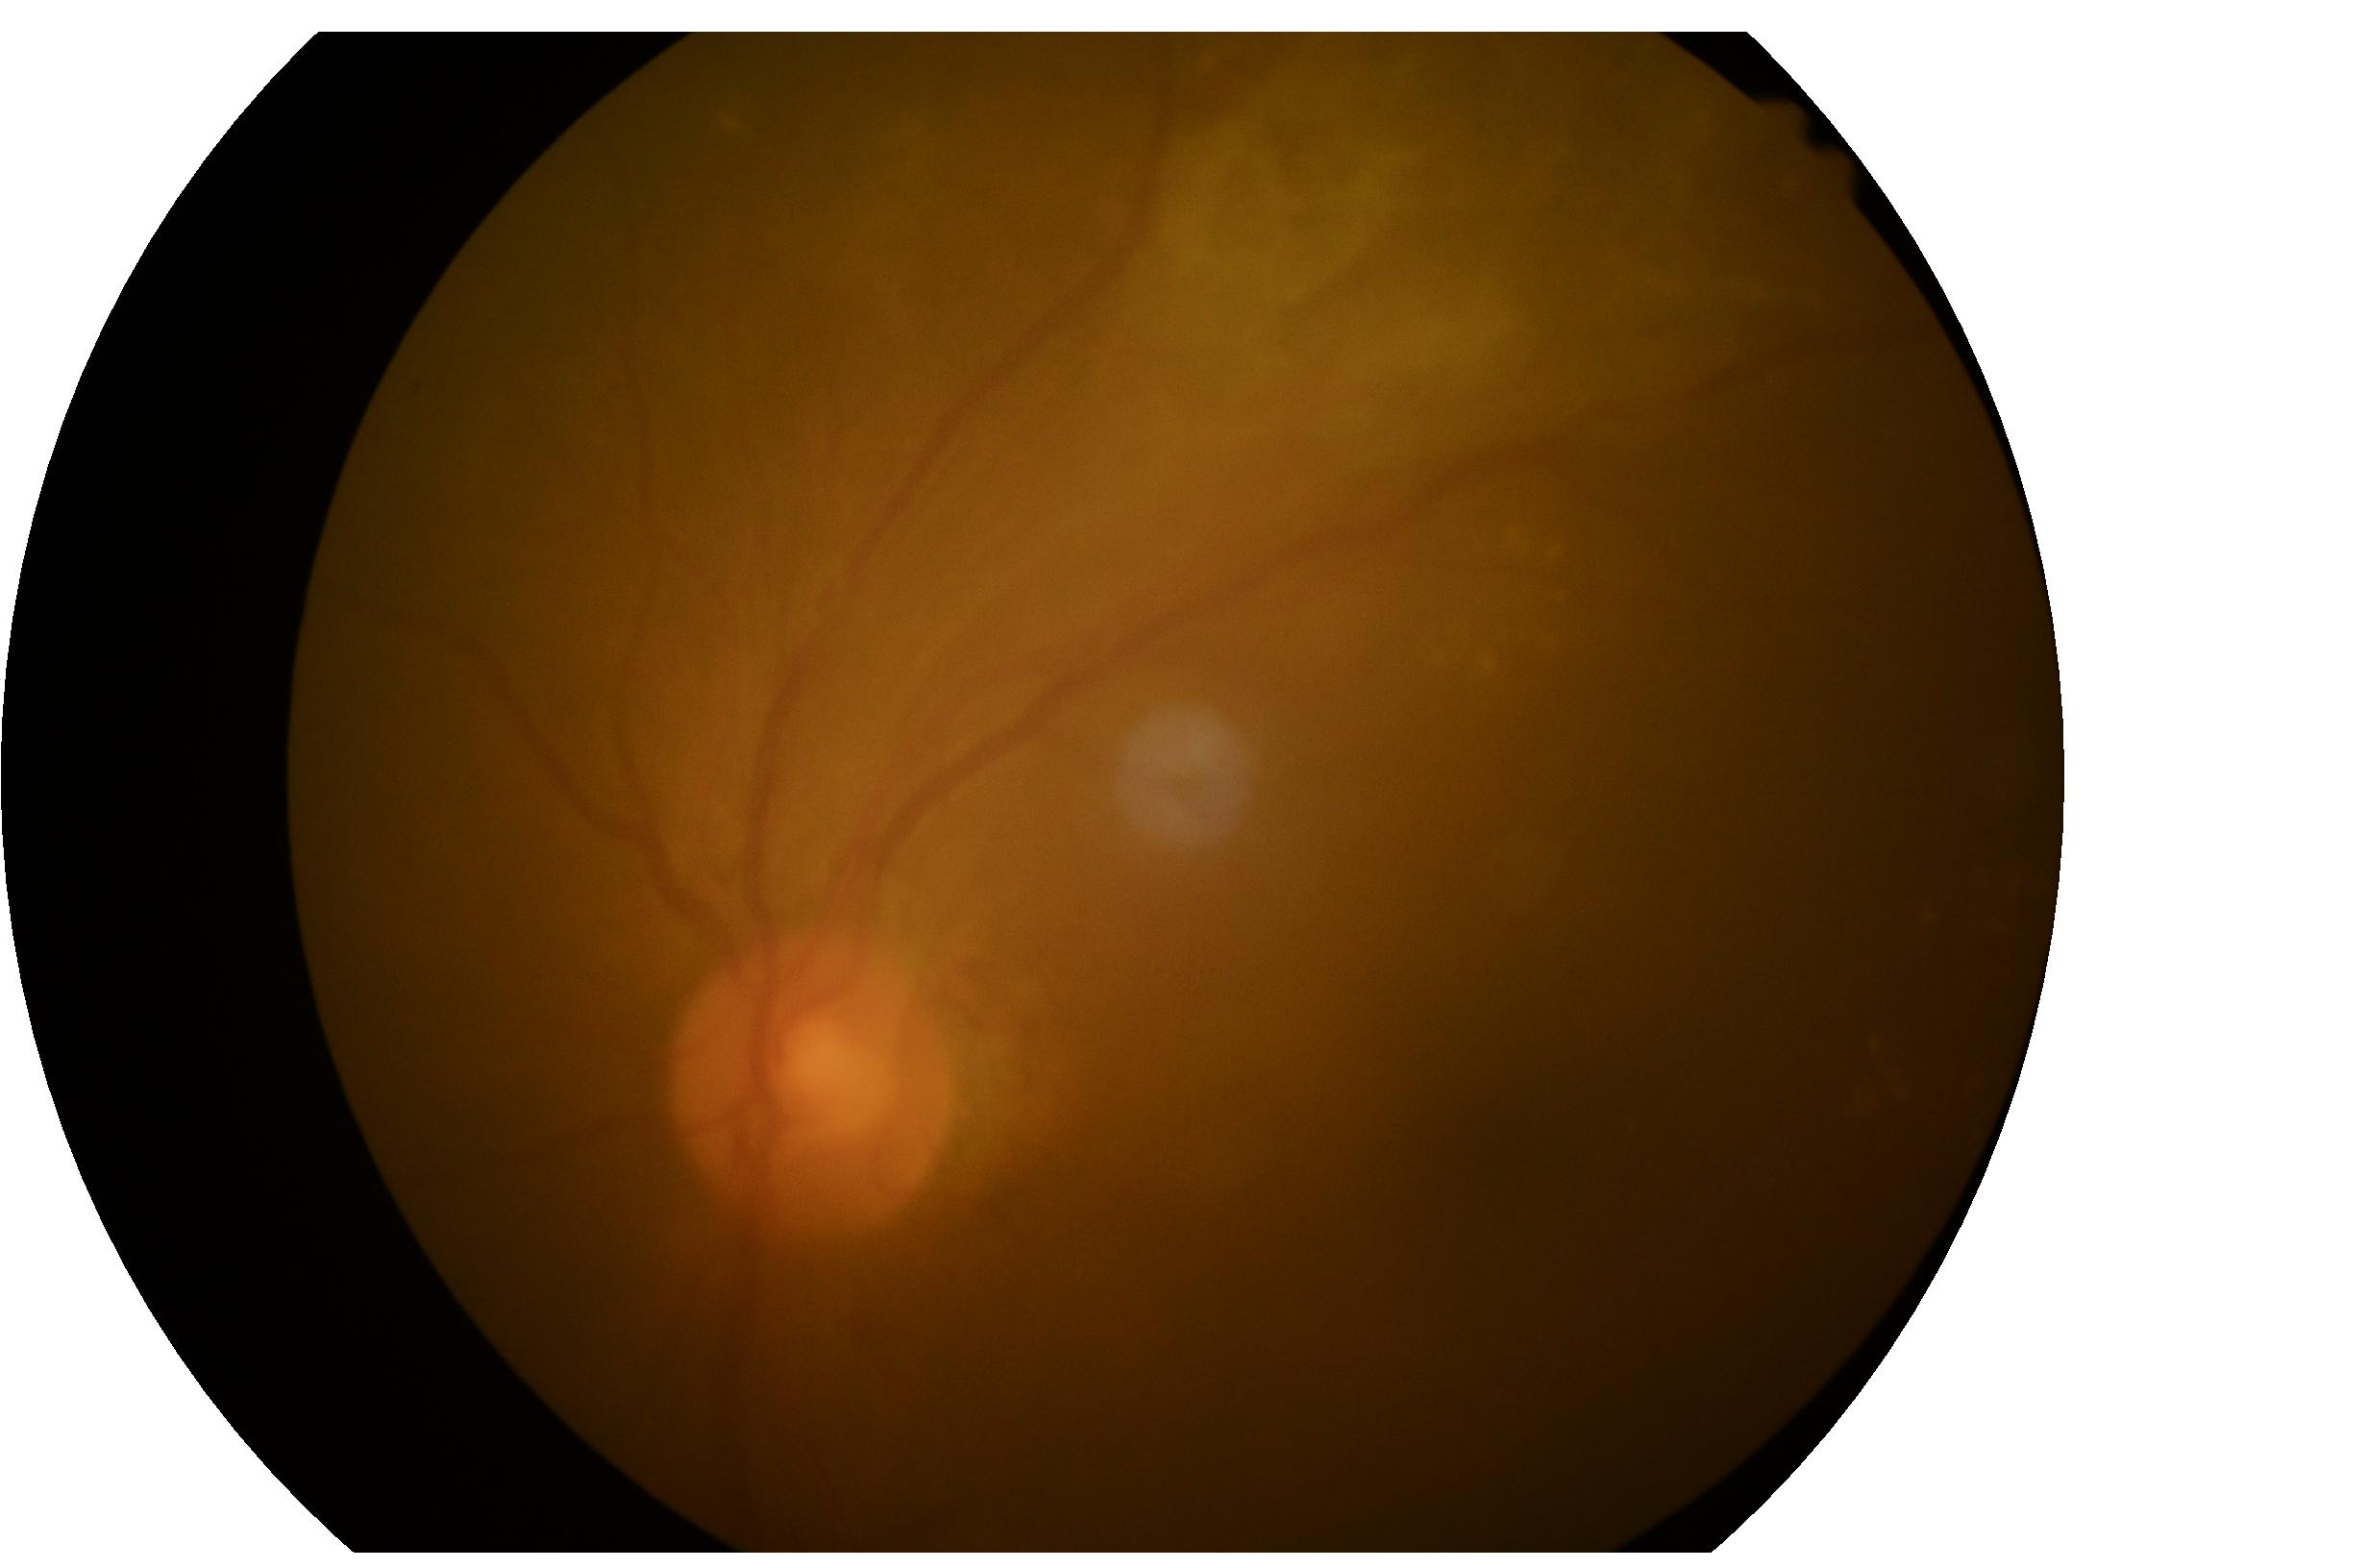 DR class: proliferative diabetic retinopathy.
DR grade is 4/4 — neovascularization and/or vitreous/pre-retinal hemorrhage.